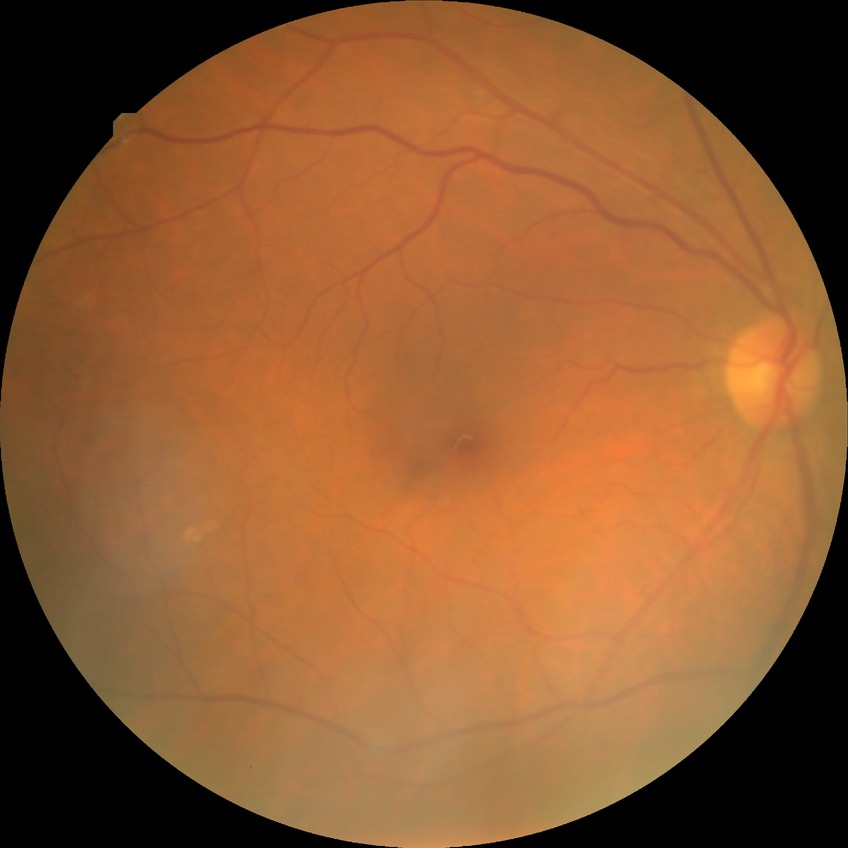
Diabetic retinopathy stage: simple diabetic retinopathy.